848x848px
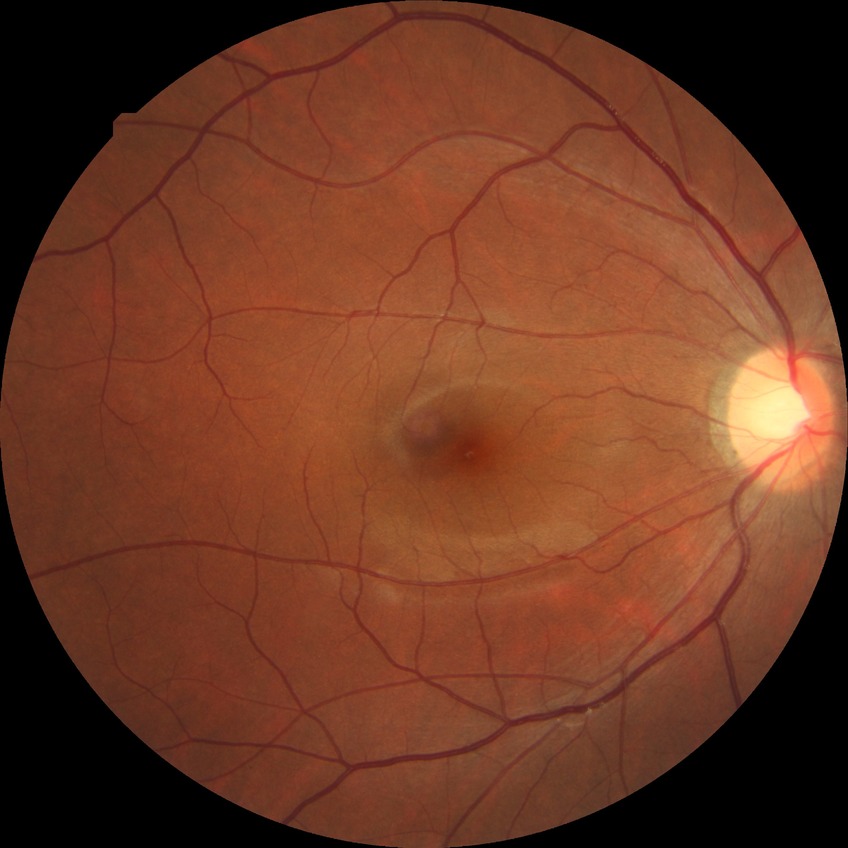

- retinopathy grade — no diabetic retinopathy